Modified Davis classification. 45-degree field of view. Image size 848x848 — 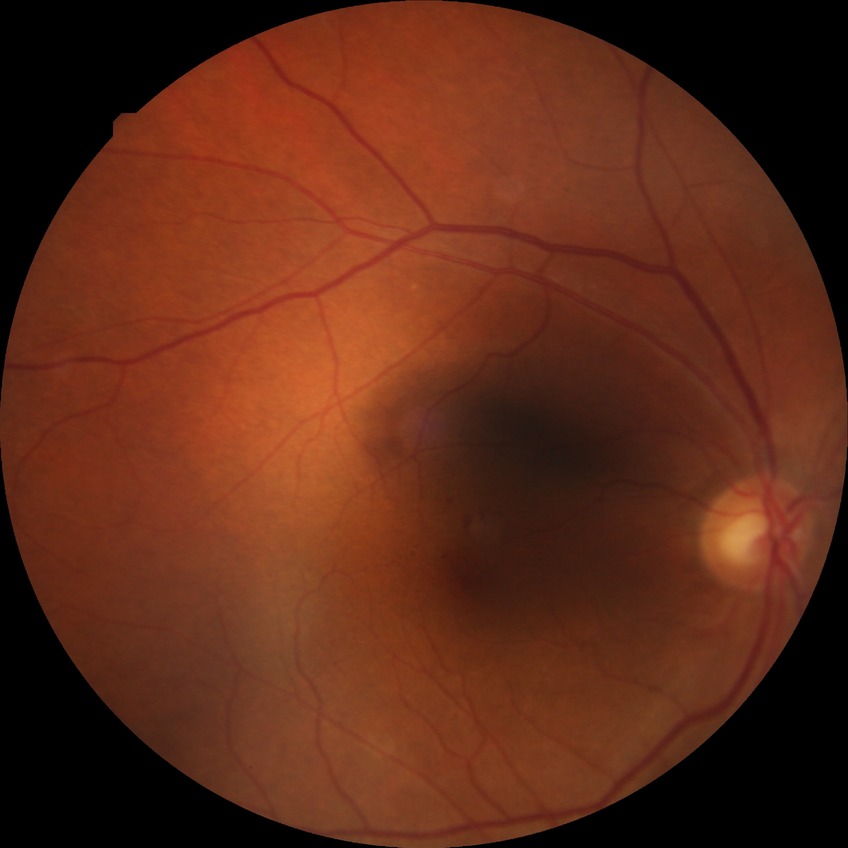 Diabetic retinopathy (DR): simple diabetic retinopathy (SDR).